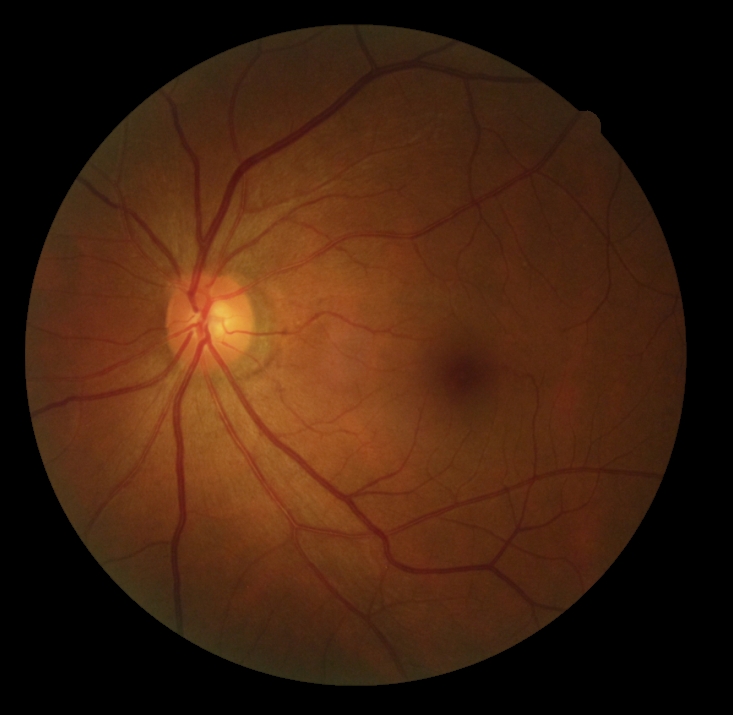
DR stage = grade 0 (no apparent retinopathy).